Camera: NIDEK AFC-230. 45° FOV. Davis DR grading
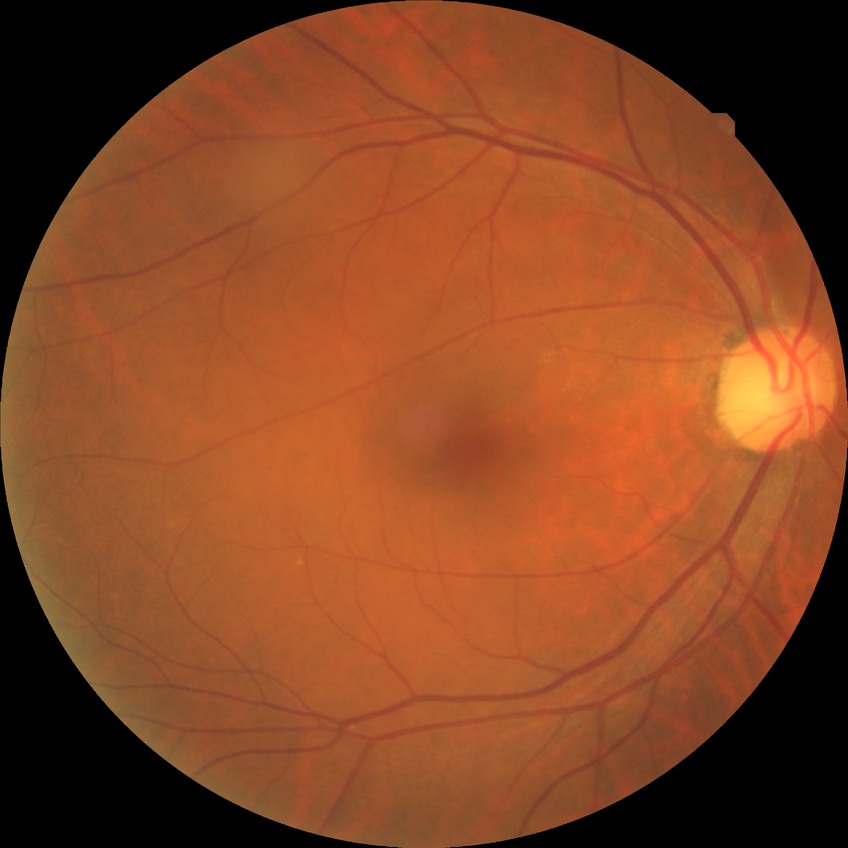
Diabetic retinopathy (DR): no diabetic retinopathy (NDR).